Wide-field fundus photograph from neonatal ROP screening; acquired on the Clarity RetCam 3 — 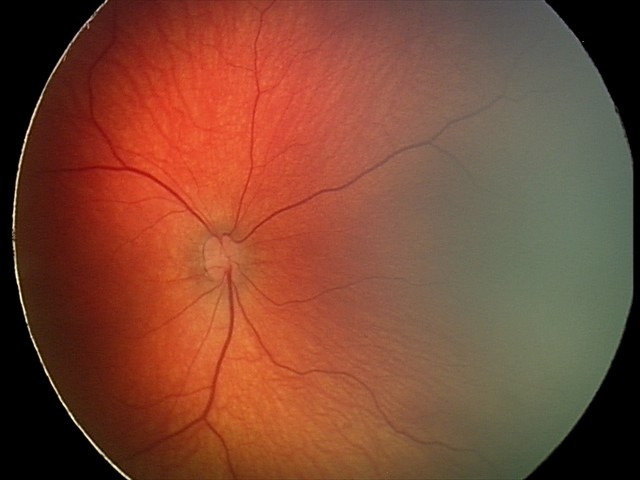

Q: What is the diagnosis from this examination?
A: retinal hemorrhages